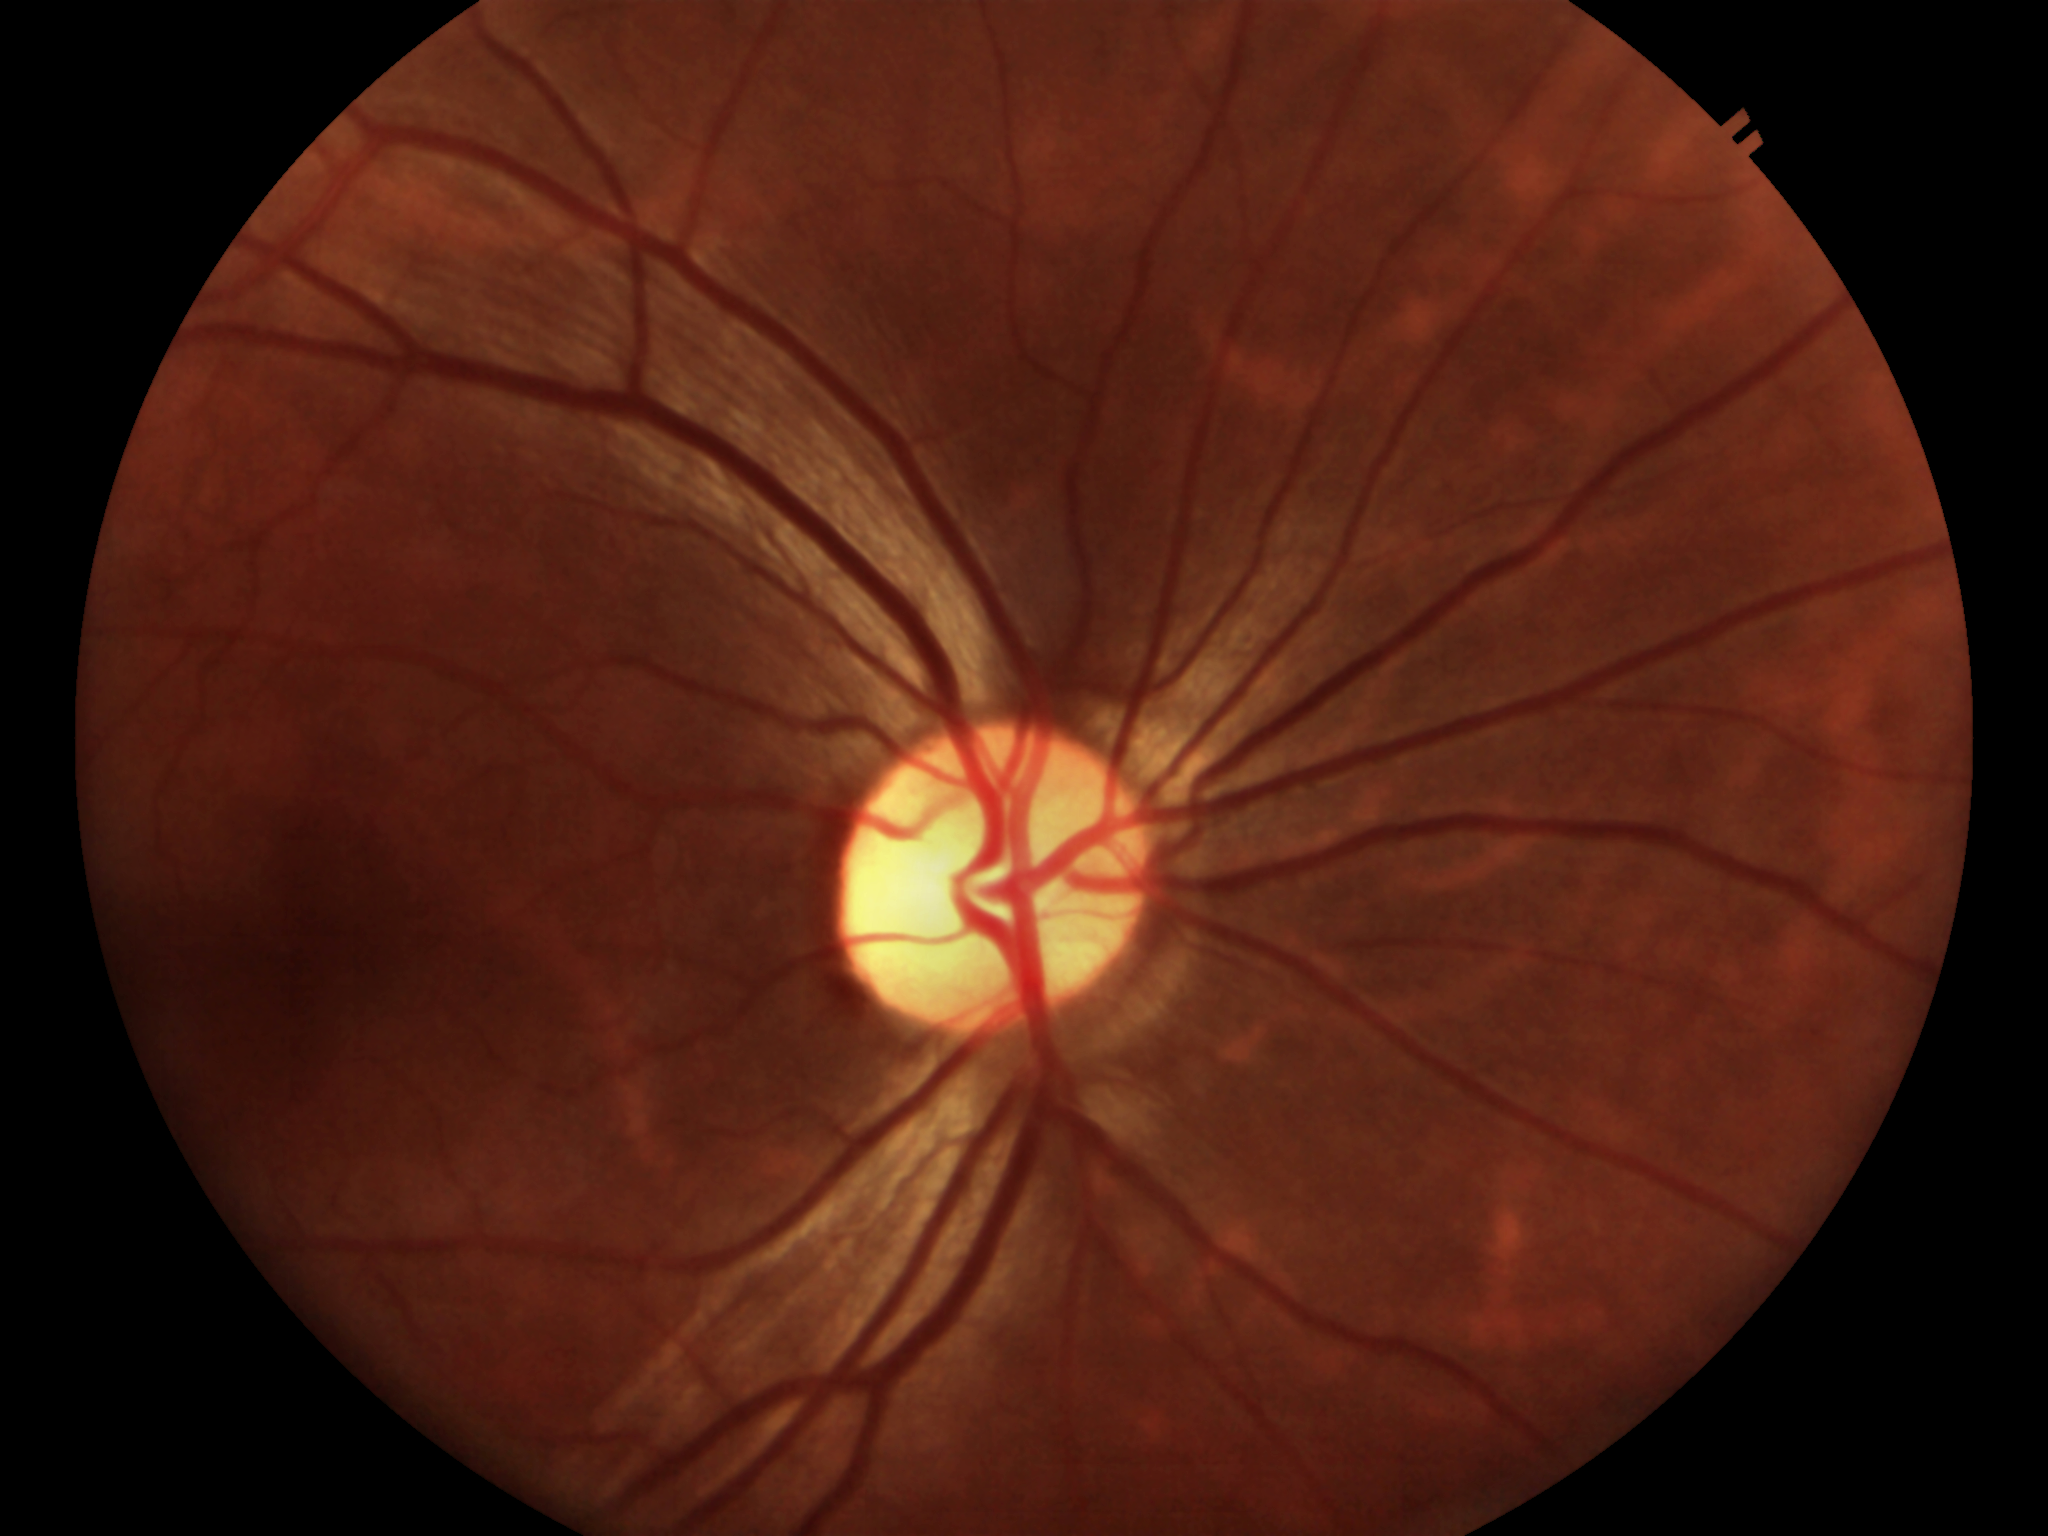 Horizontal CDR (HCDR): 0.55.
No glaucomatous optic neuropathy.
Vertical cup-to-disc ratio (VCDR) is 0.59.